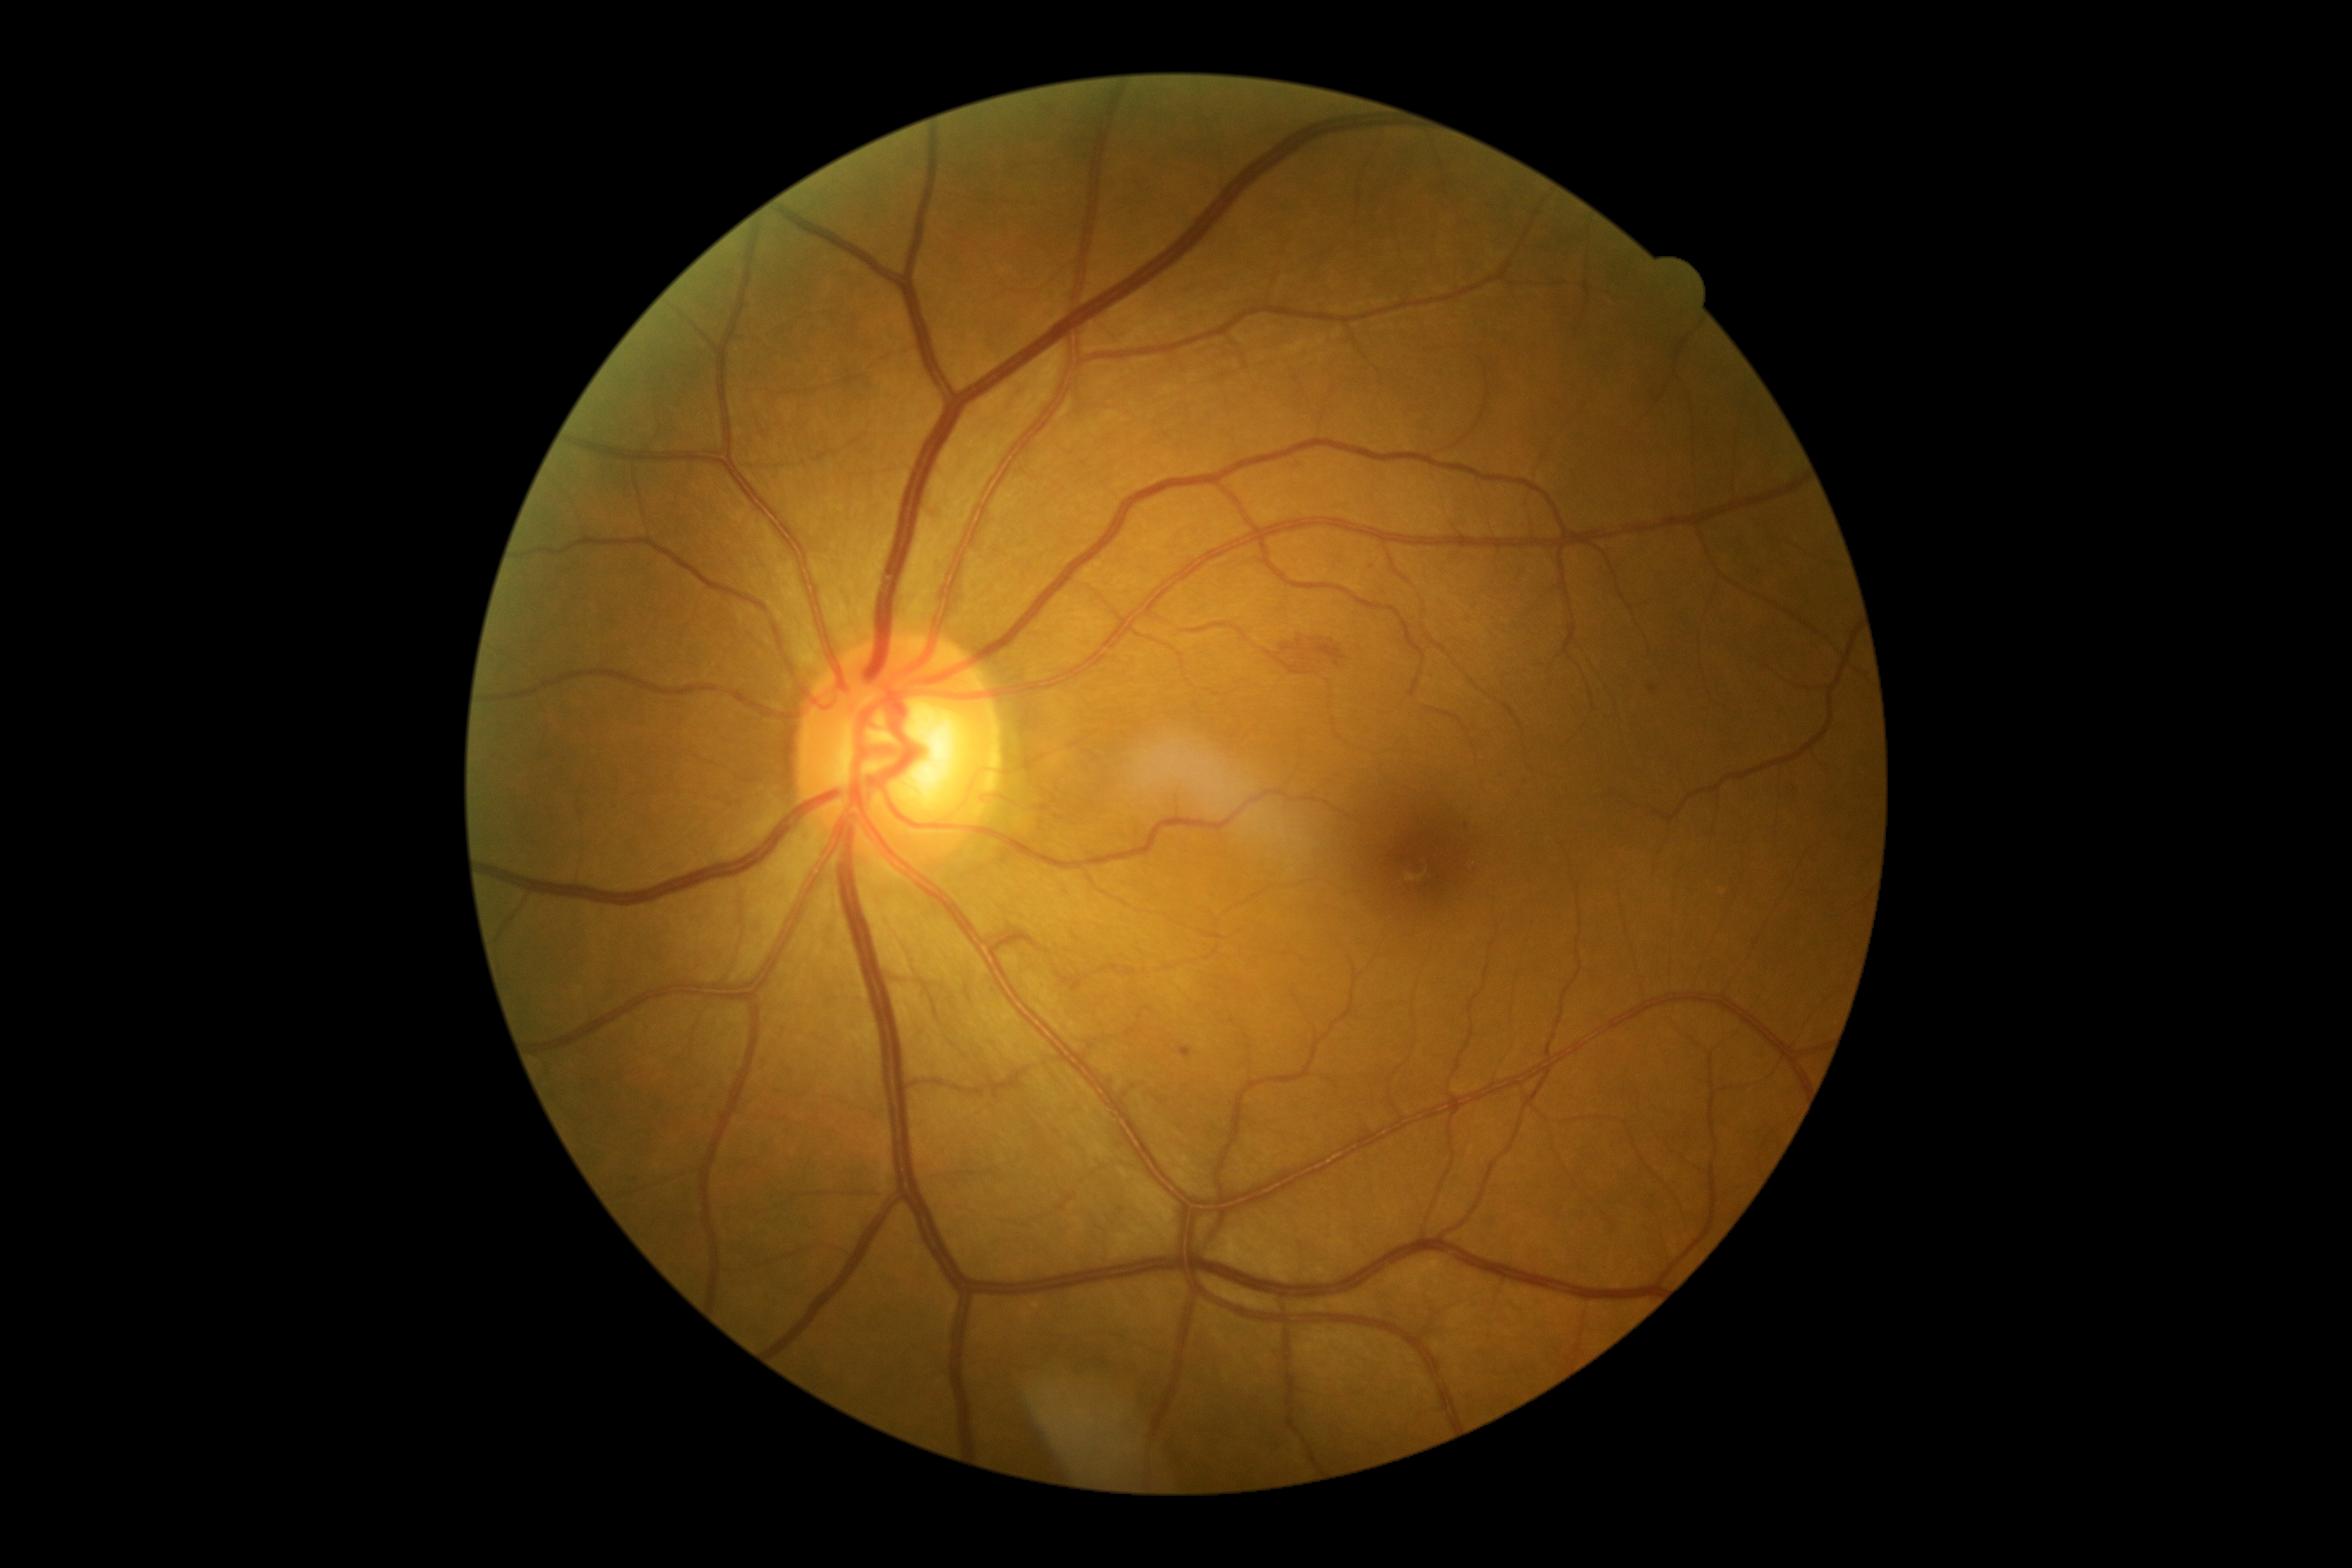 DR: moderate NPDR (grade 2). No EXs identified. HEs are located at [1650,685,1657,694]; [1282,632,1351,665]. No SEs identified. MAs are located at [1179,1046,1192,1060]. MAs (small, approximate centers) near x=1467, y=827.